45 degree fundus photograph — 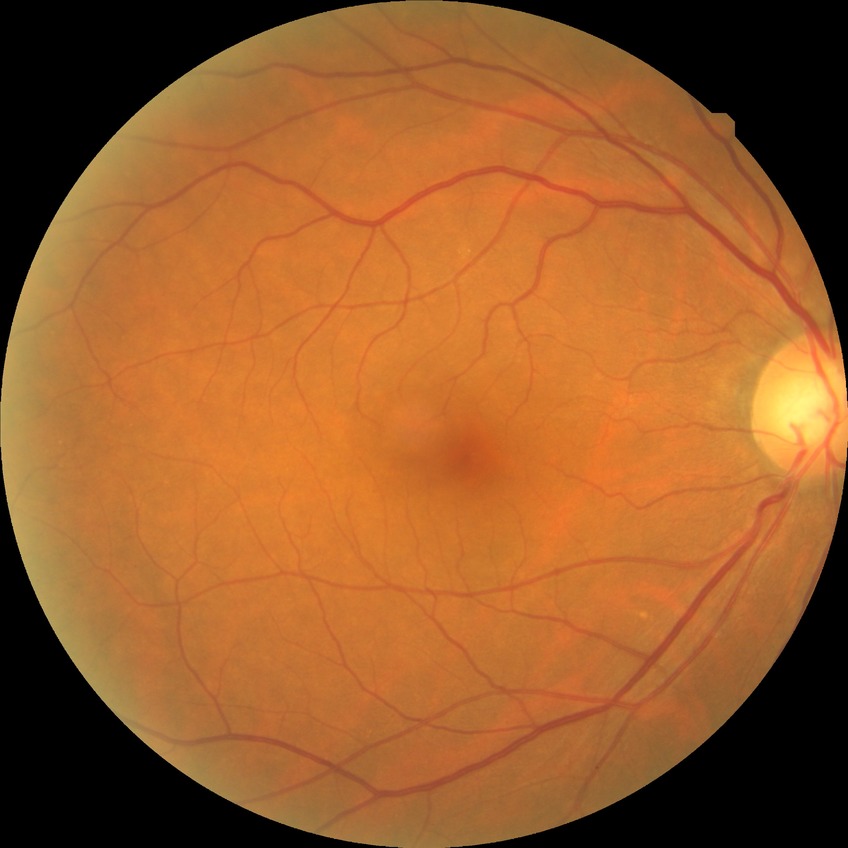

Modified Davis grading: no diabetic retinopathy.